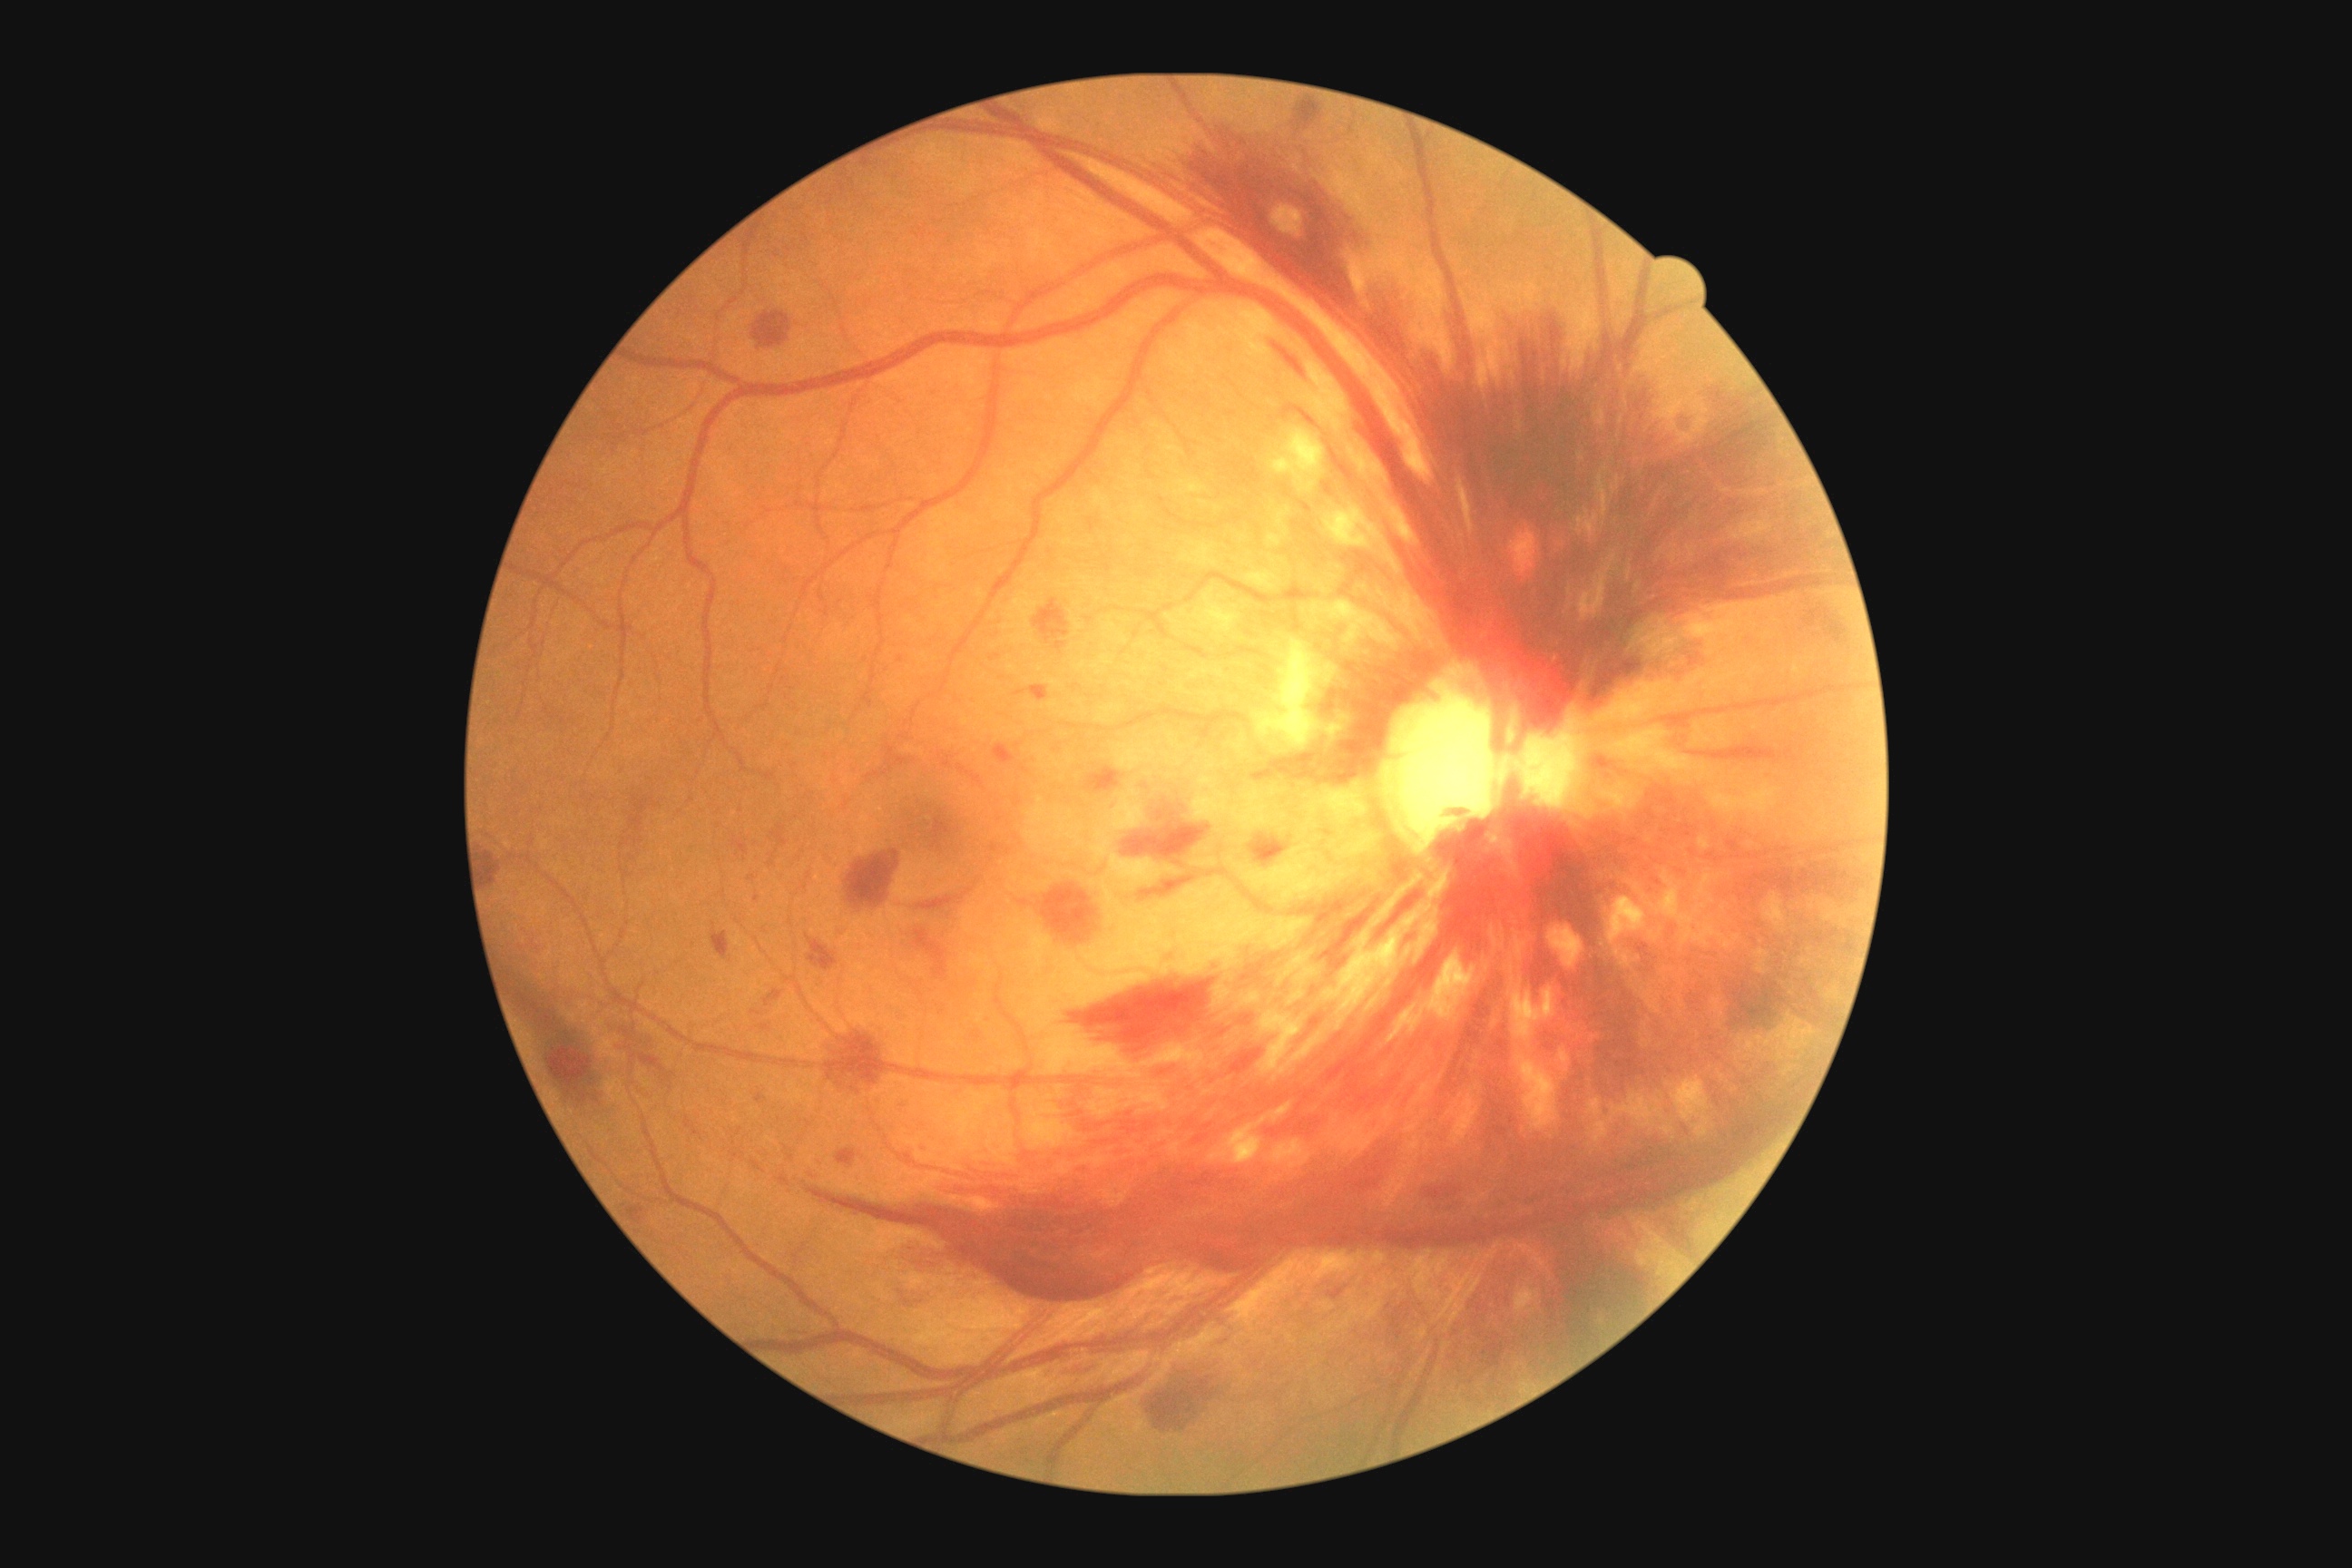 DR: grade 4 (PDR).